Image size 2184x1690:
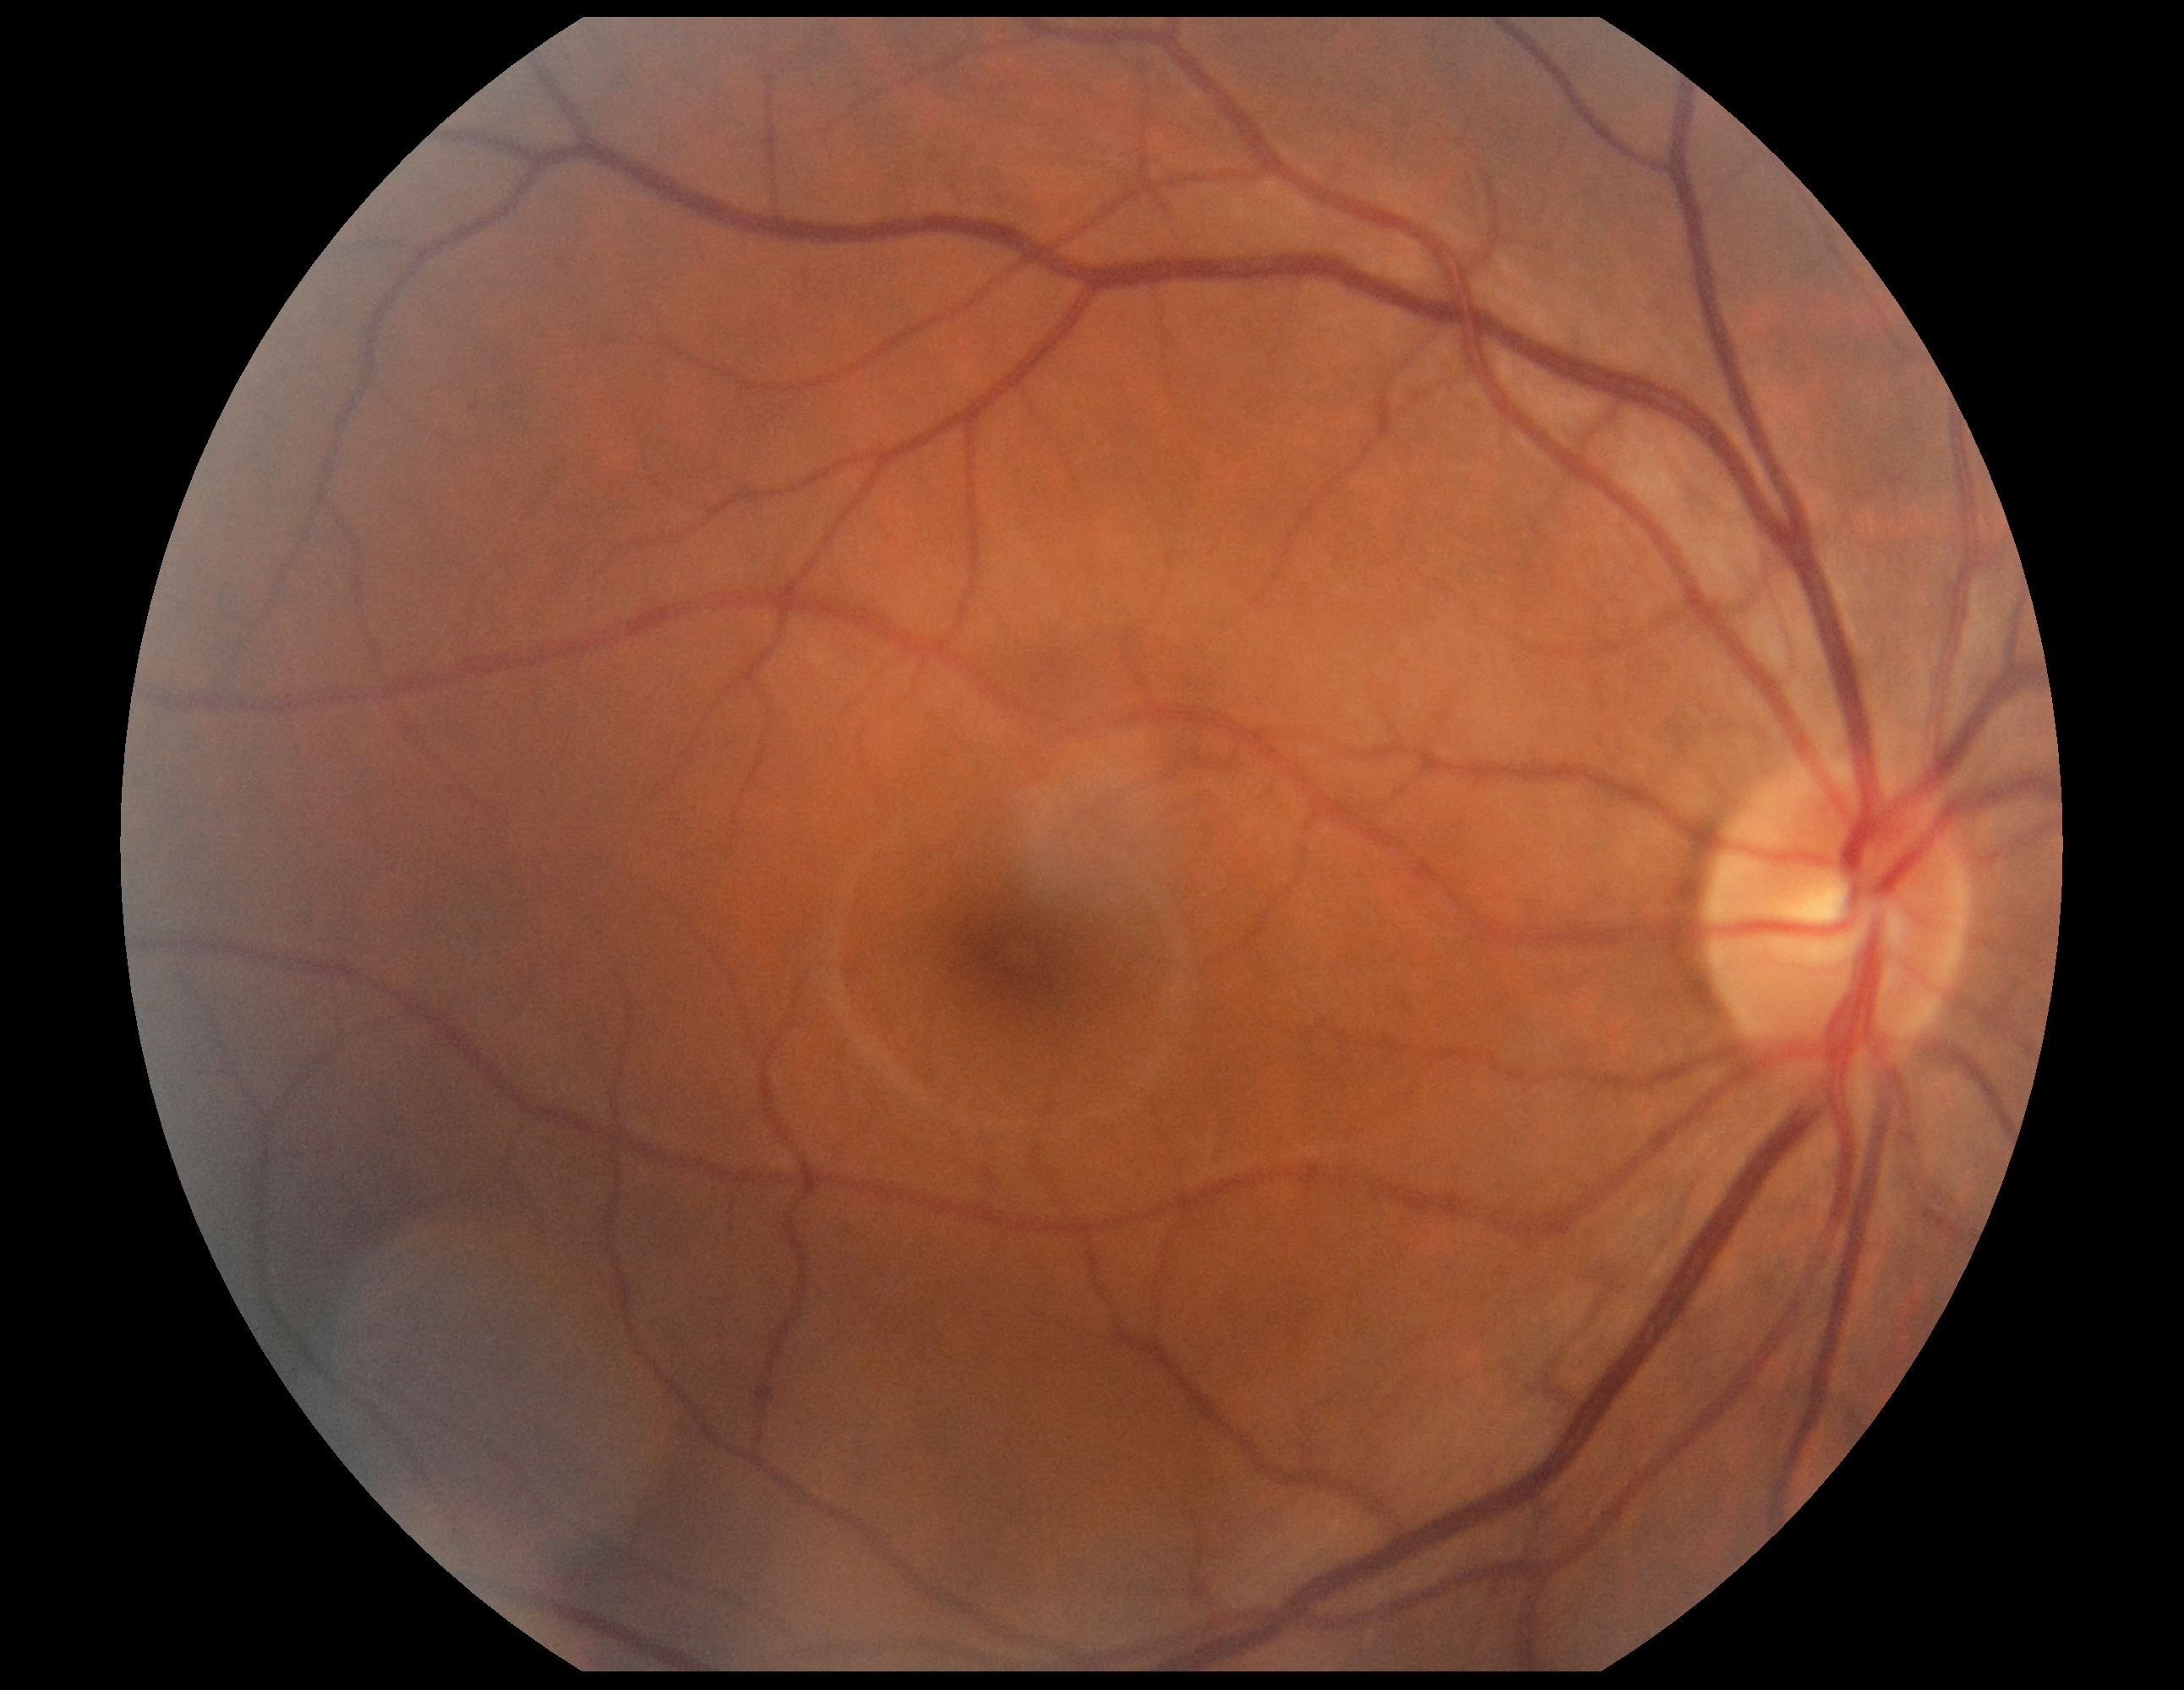 dr_grade: 0